1936x1296. 45° field of view
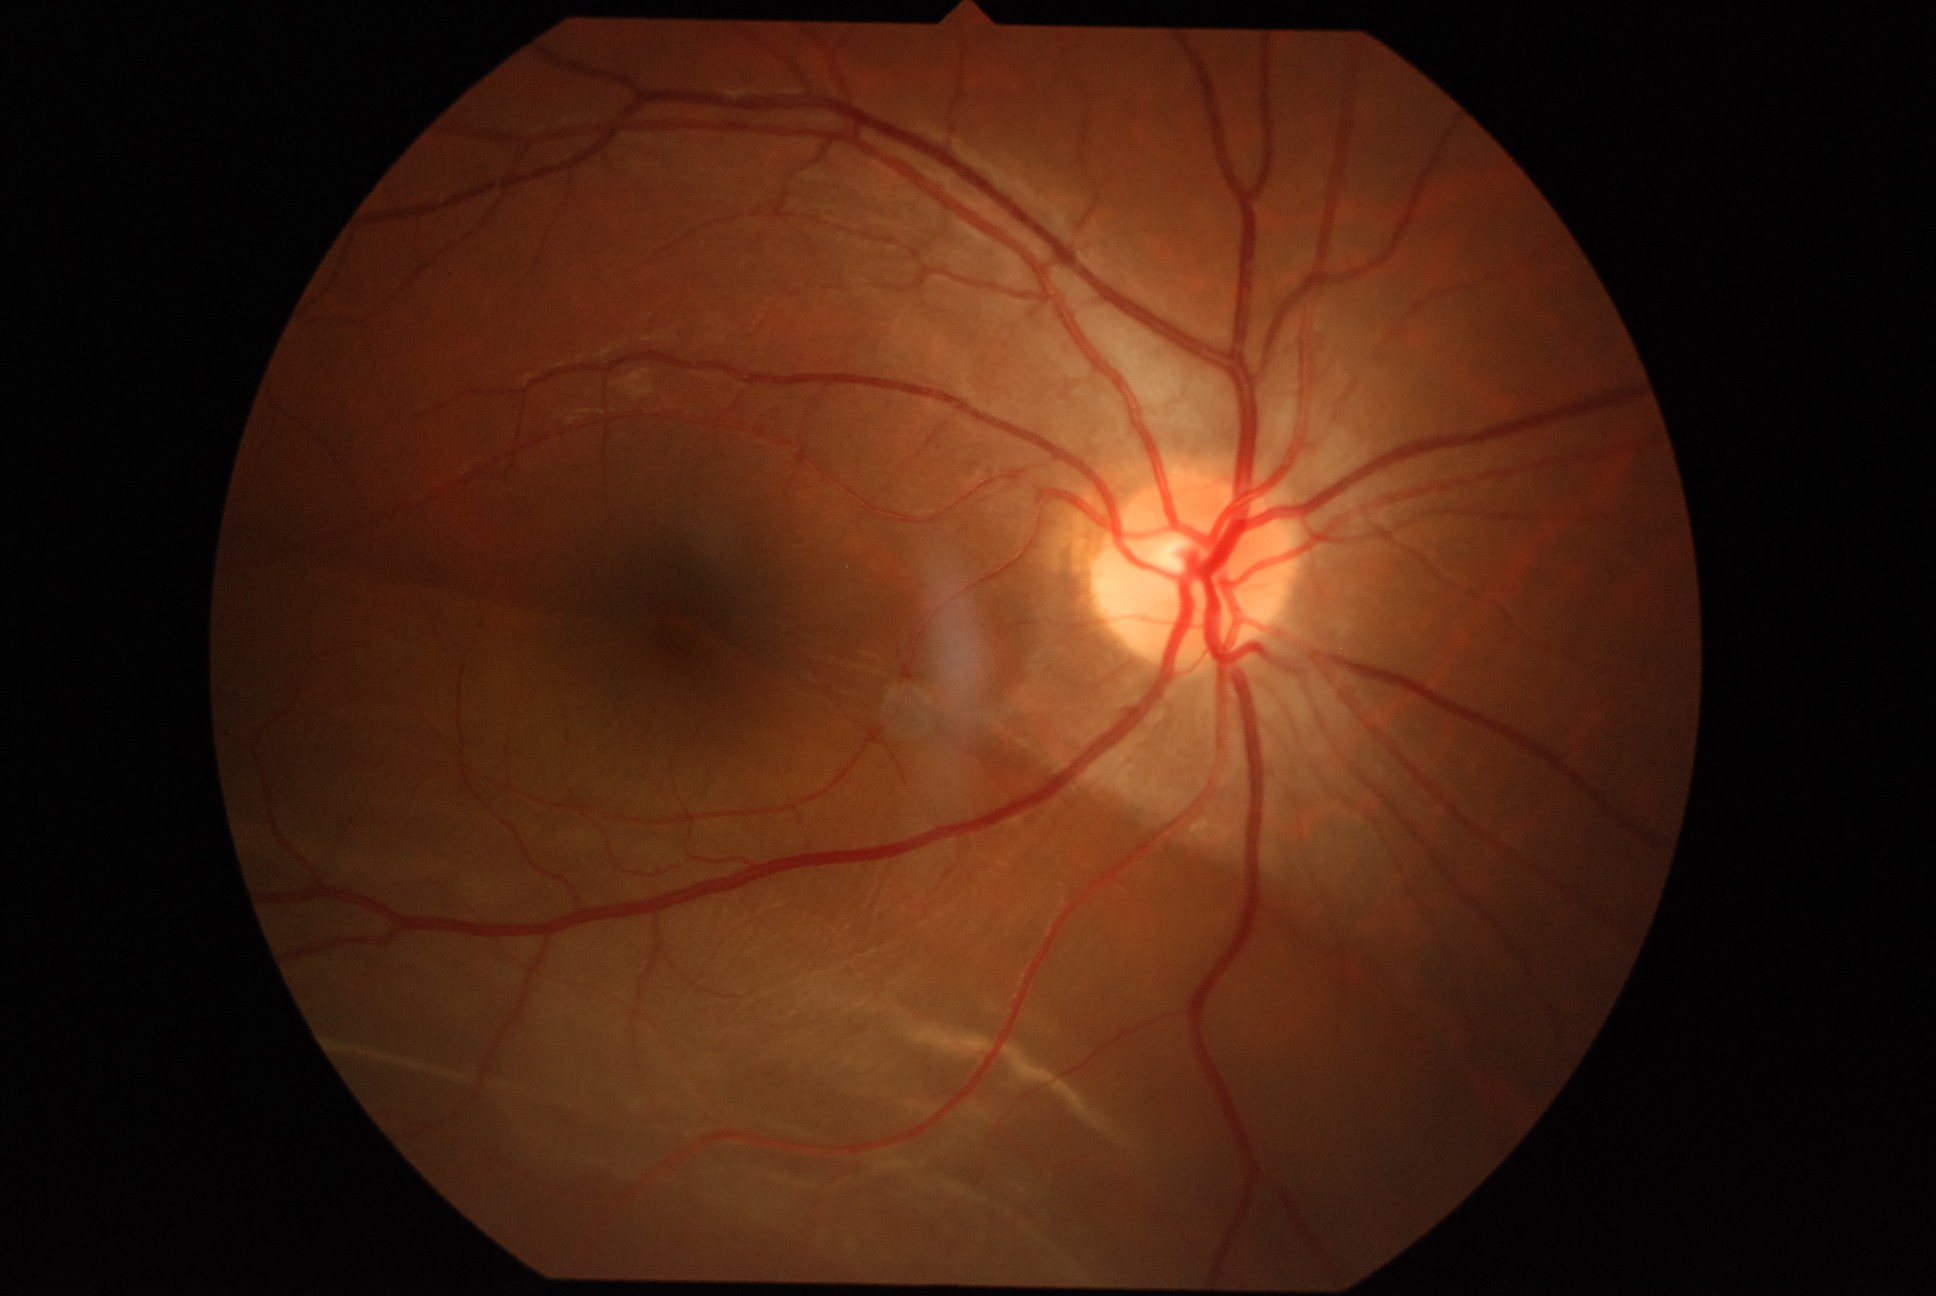 Diabetic retinopathy (DR) is grade 4 (PDR).
DR class: proliferative diabetic retinopathy.